45-degree field of view.
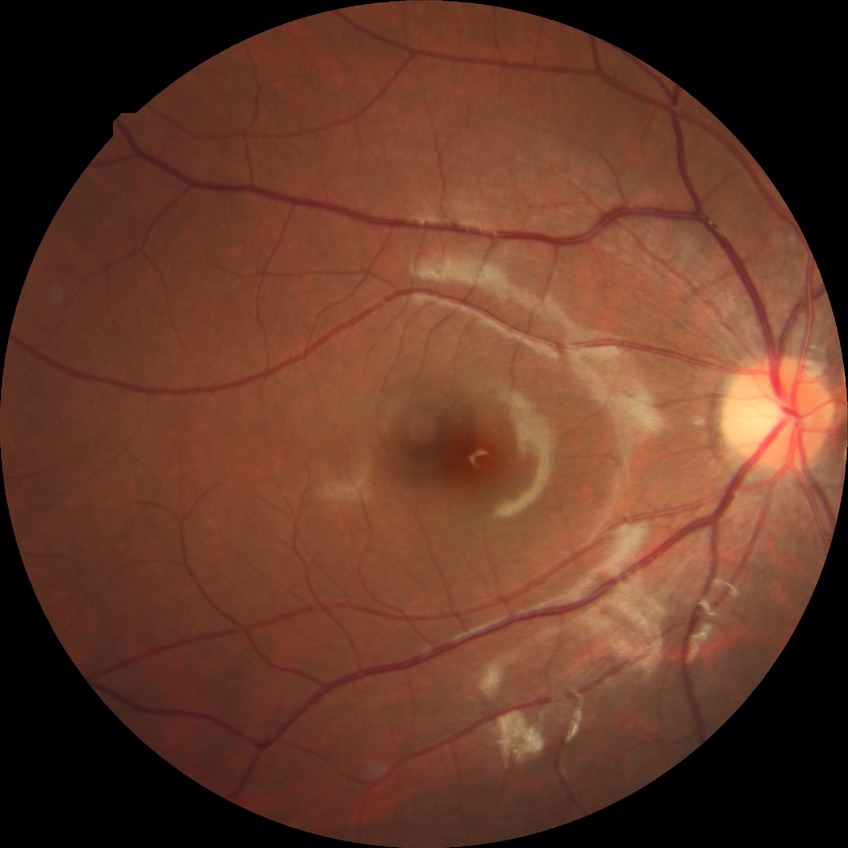

No apparent diabetic retinopathy. DR is NDR.